Nonmydriatic; 45 degree fundus photograph.
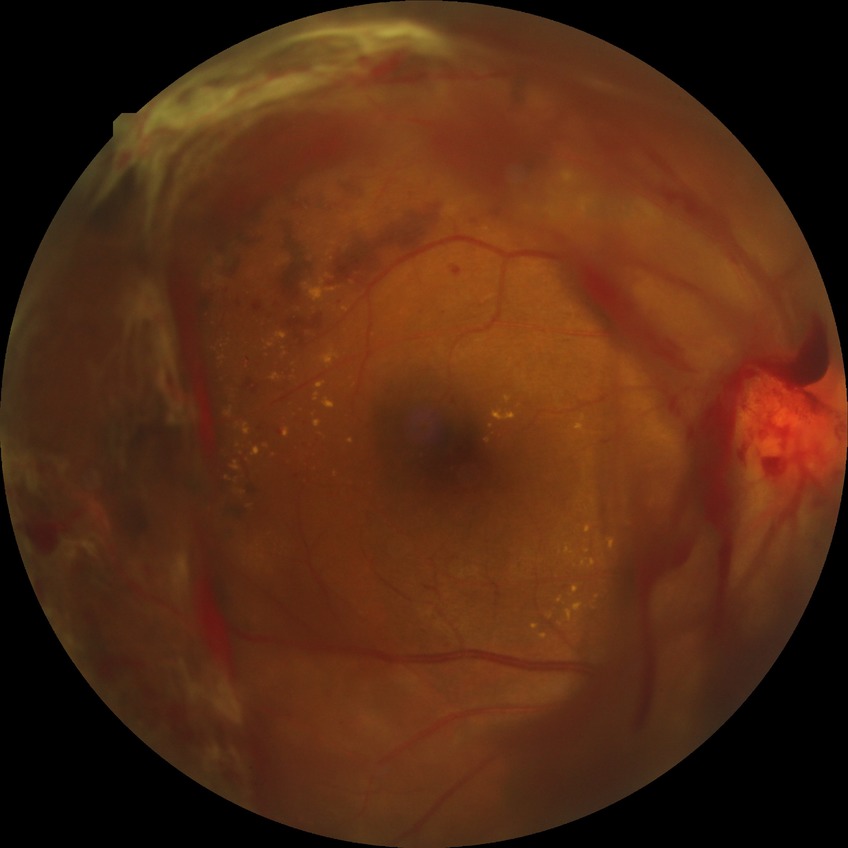 Diabetic retinopathy (DR) is PDR (proliferative diabetic retinopathy).